Acquired on the Phoenix ICON · wide-field fundus photograph of an infant.
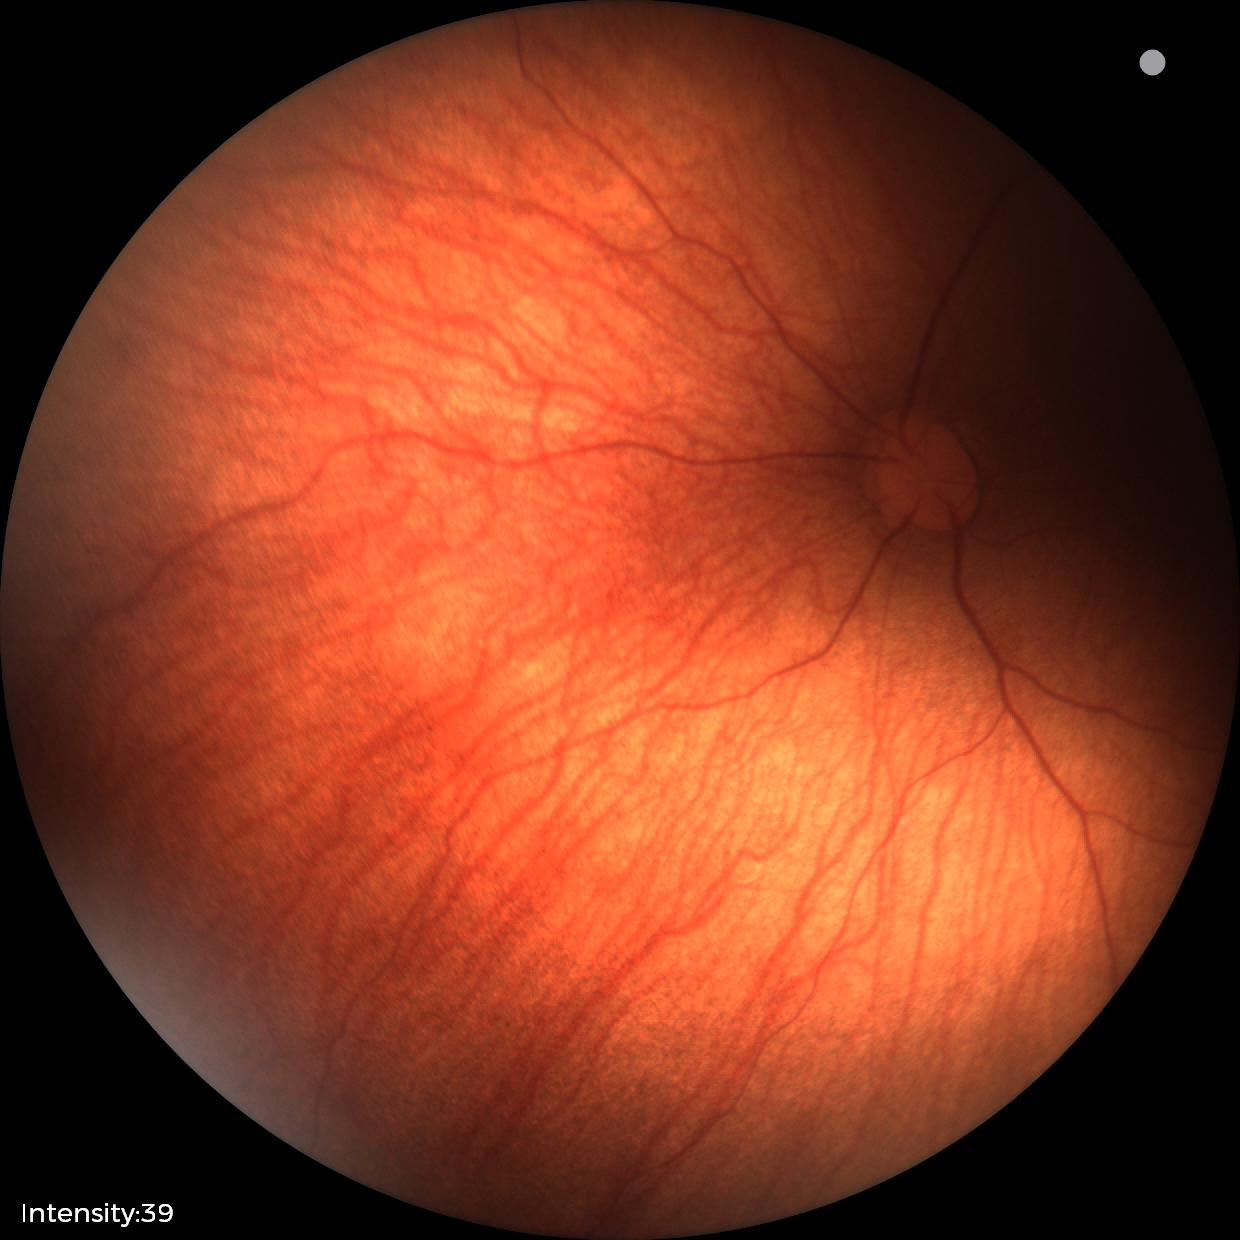

Screening diagnosis: retinal hemorrhages.